Pediatric retinal photograph (wide-field) · acquired on the Clarity RetCam 3
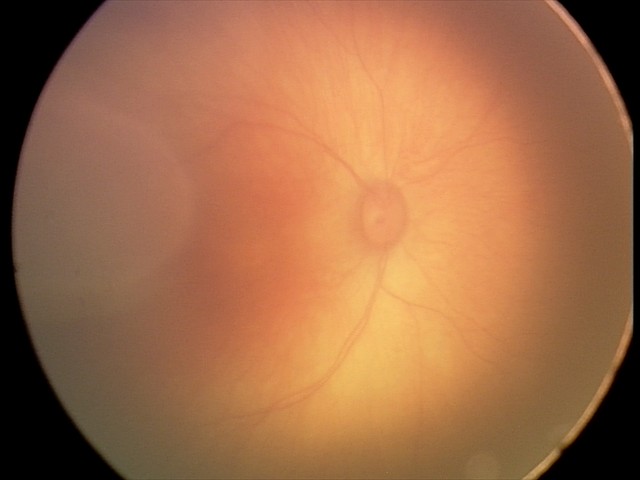
Assessment = retinal hemorrhages.